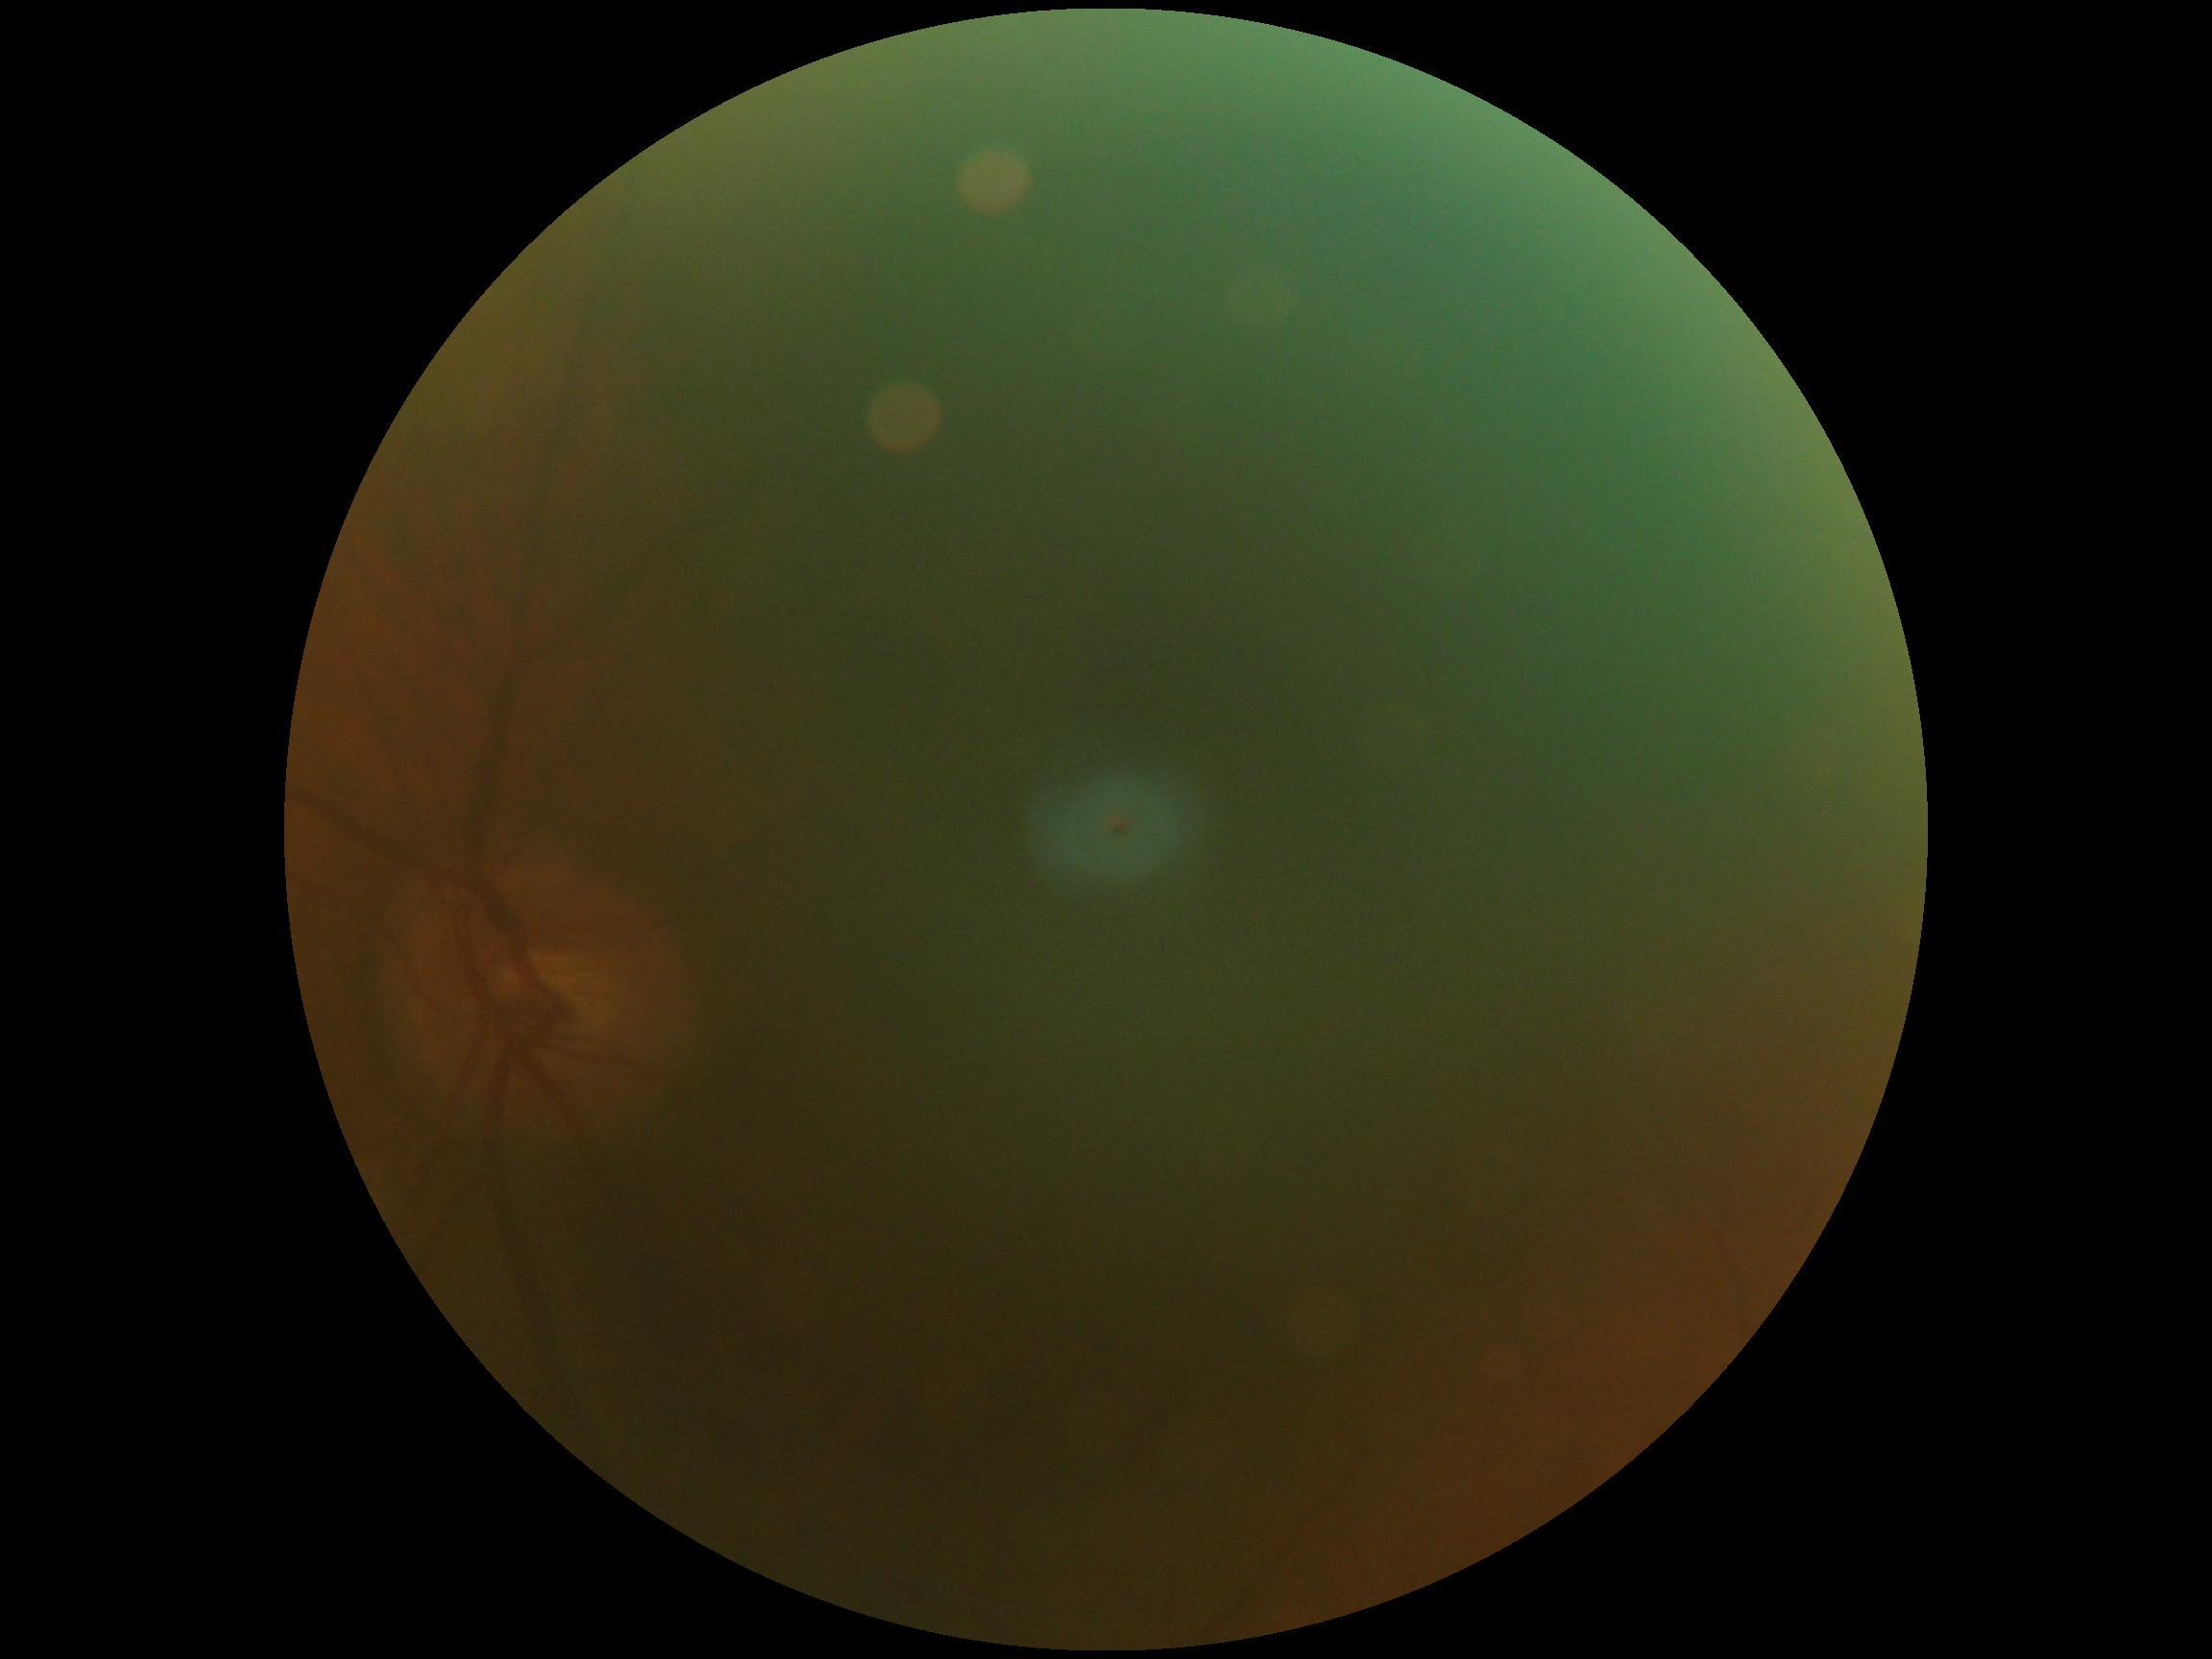

Quality too poor to assess for DR. Retinopathy: ungradable due to poor image quality.